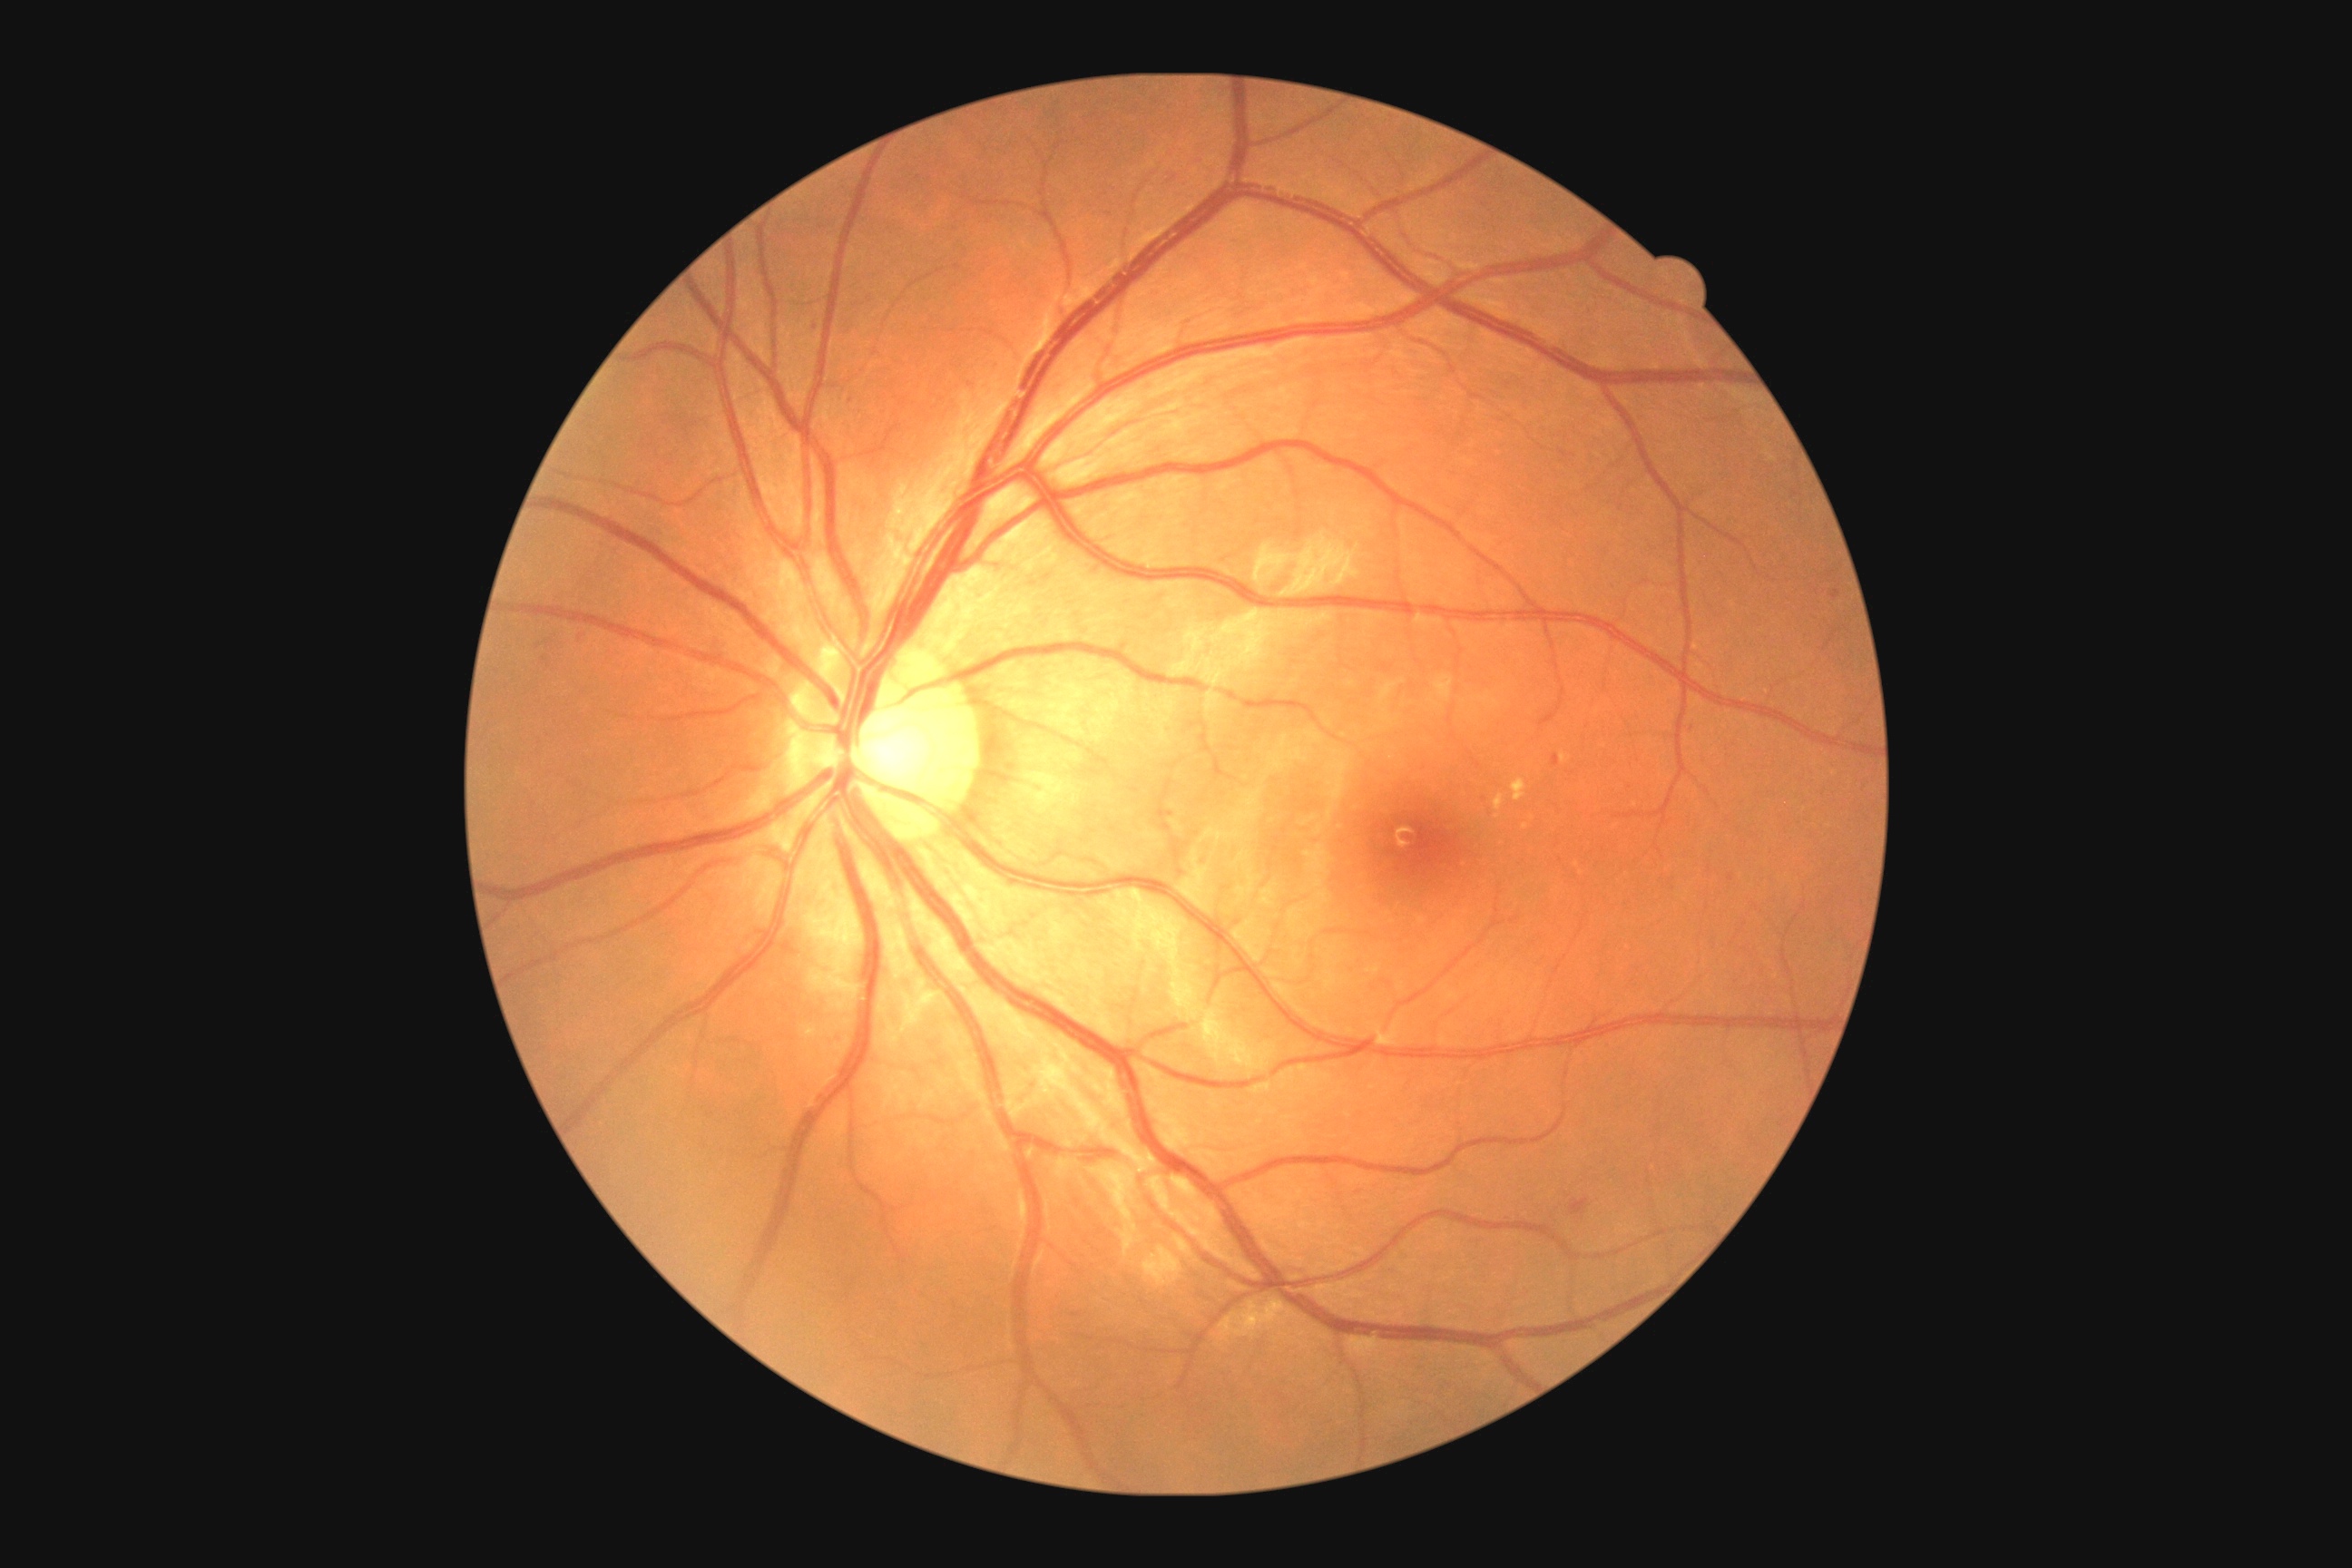 dr_grade: grade 2 (moderate NPDR)